Image size 2228x1652.
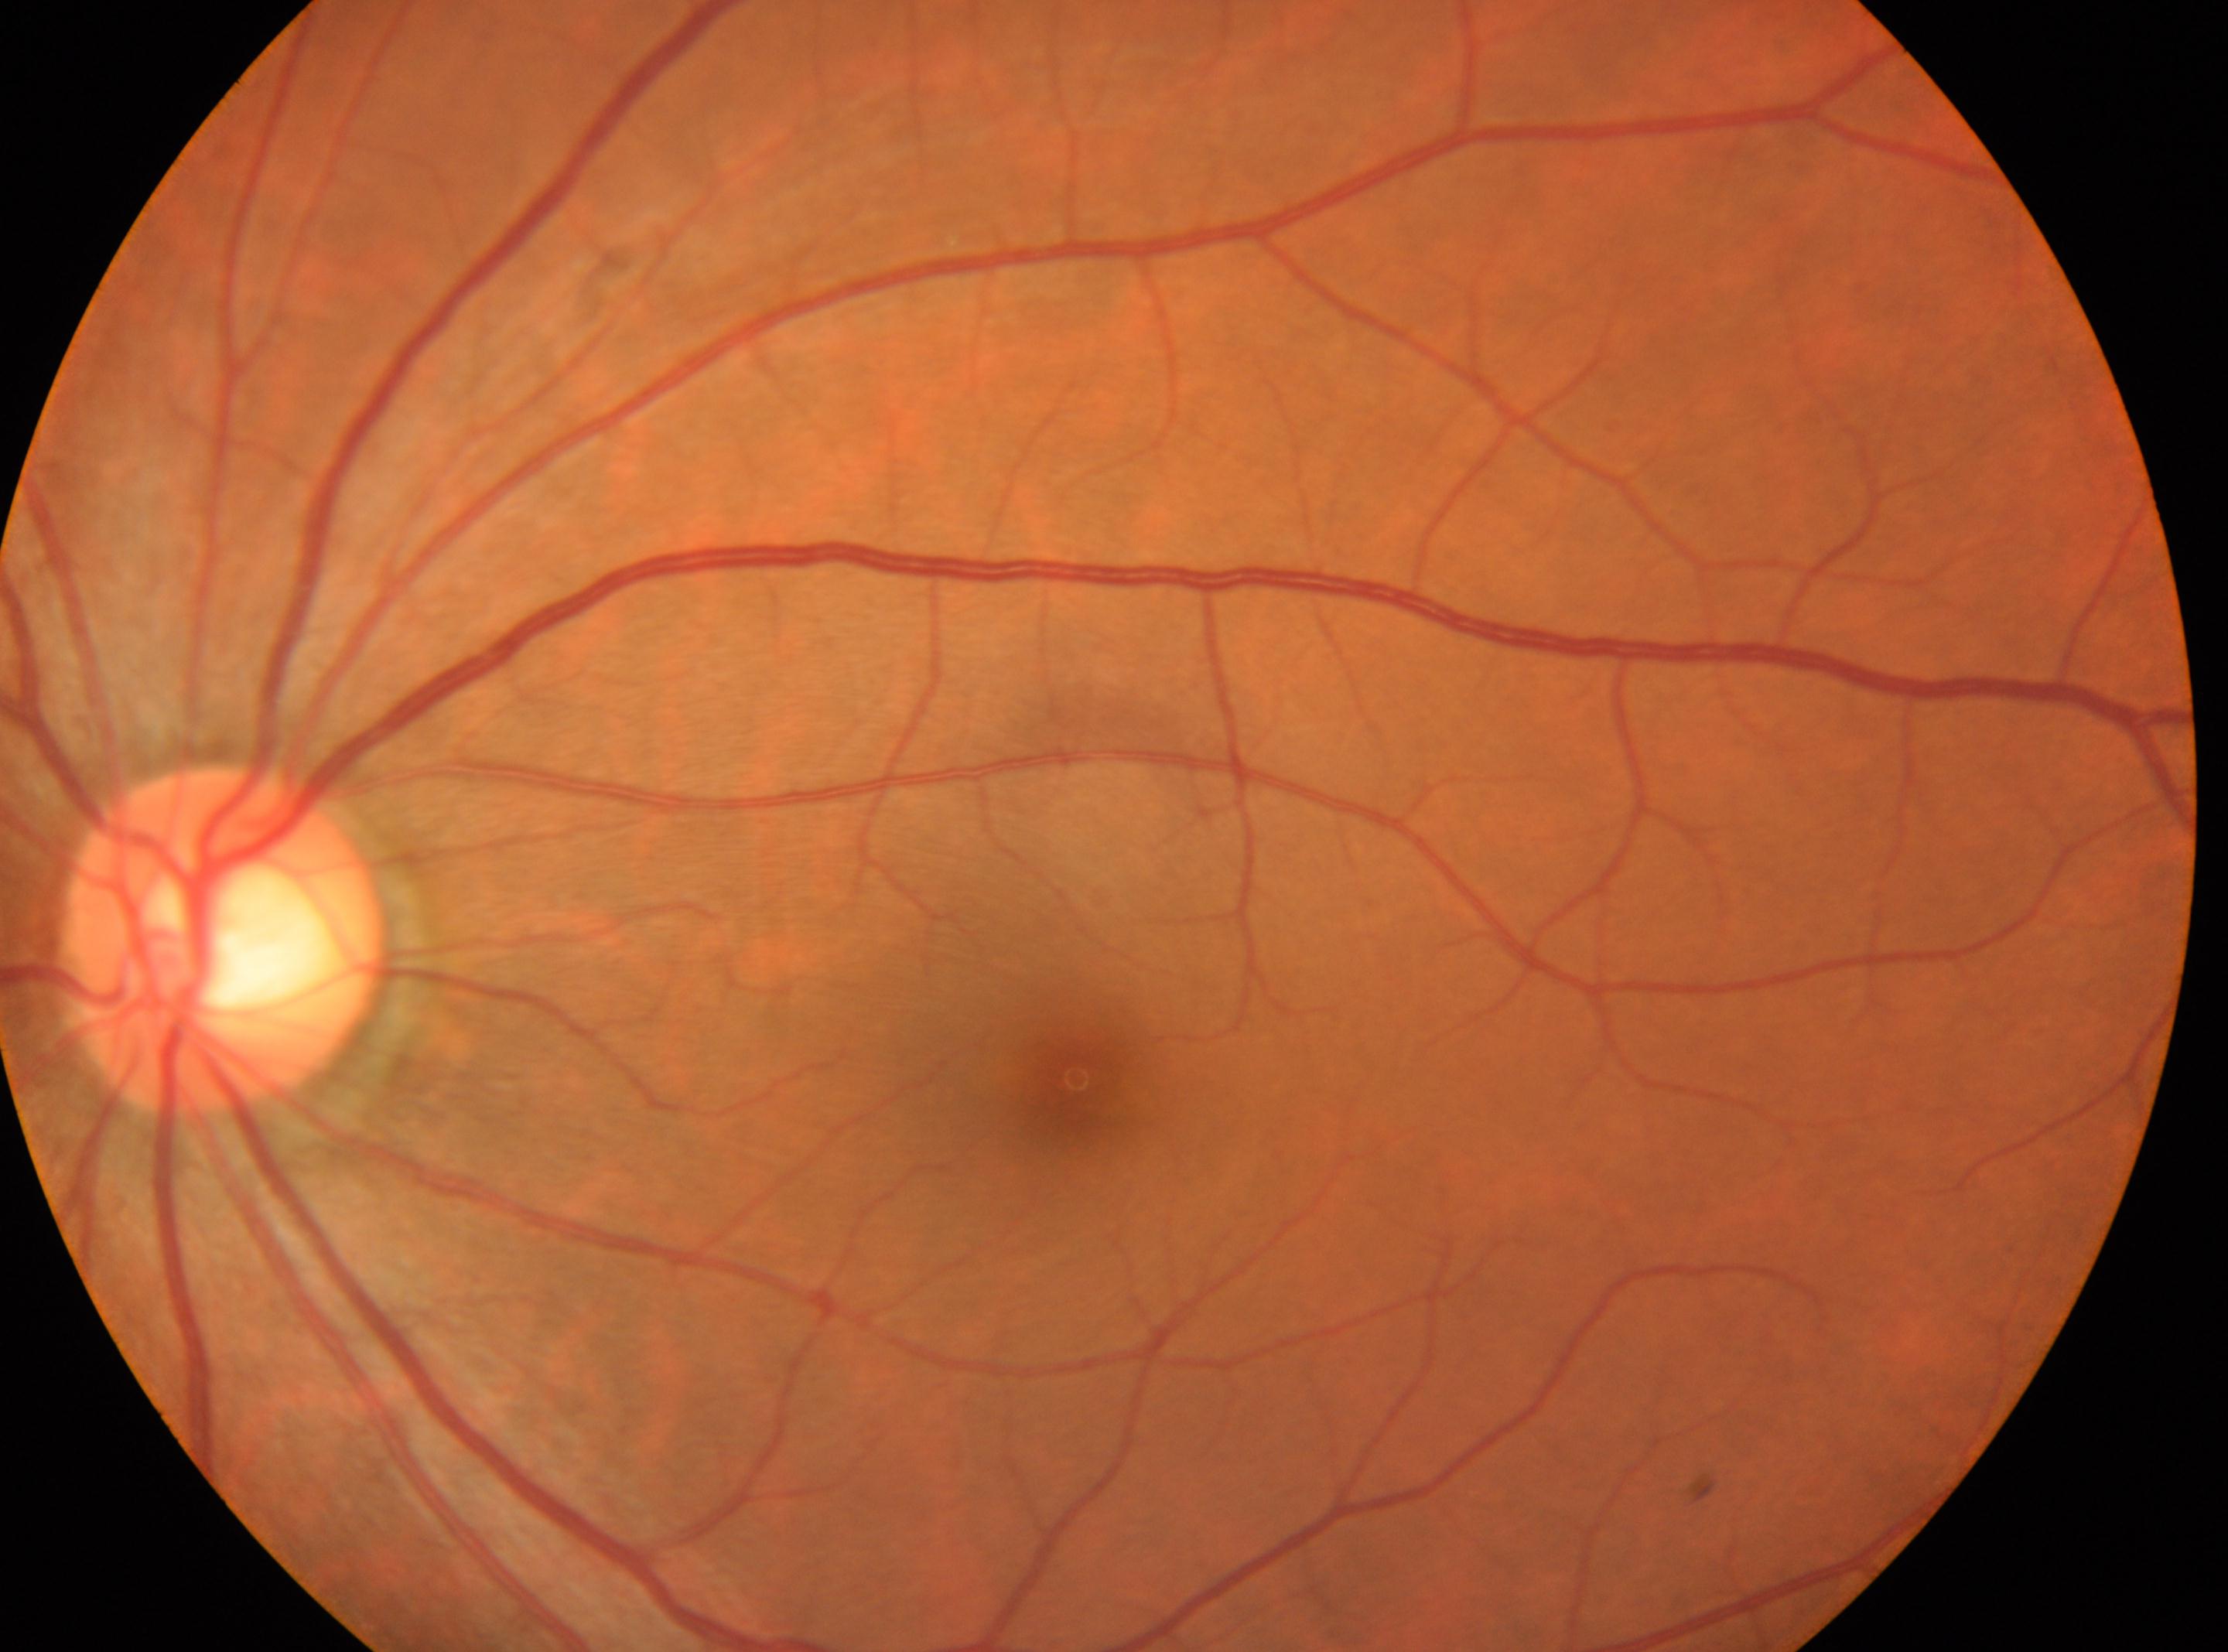 Optic nerve head located at (x=224, y=940).
Foveal center located at (x=1077, y=1078).
Eye: left.
Diabetic retinopathy (DR) is grade 0 (no apparent retinopathy).